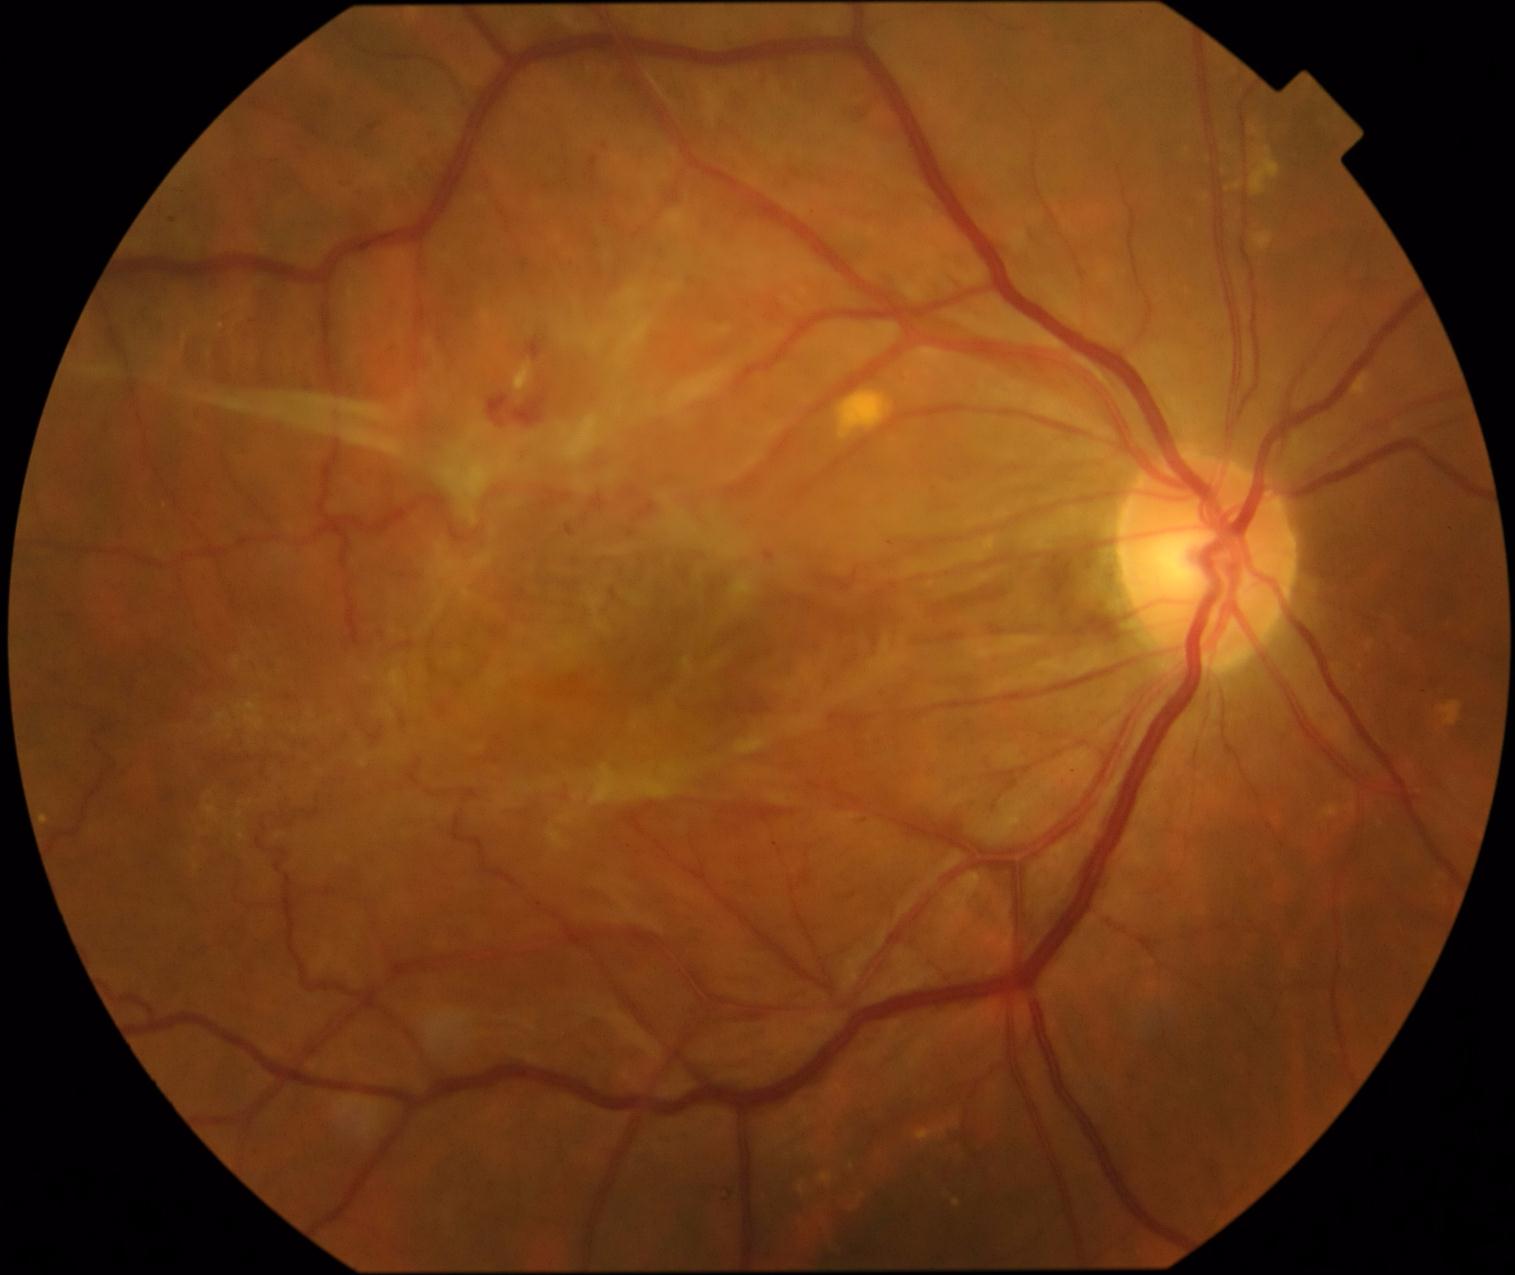

Diabetic retinopathy is grade 4 (PDR).
Hemorrhages identified at [526, 336, 543, 360], [765, 552, 775, 561], [589, 156, 599, 173], [487, 388, 549, 427], [714, 1188, 734, 1204].
Hemorrhages (small, approximate centers) near x=605, y=146, x=892, y=543.
No microaneurysms identified.
No soft exudates identified.
Hard exudates identified at [514, 363, 534, 392].